Image size 848x848; modified Davis grading; nonmydriatic; NIDEK AFC-230 fundus camera; 45-degree field of view: 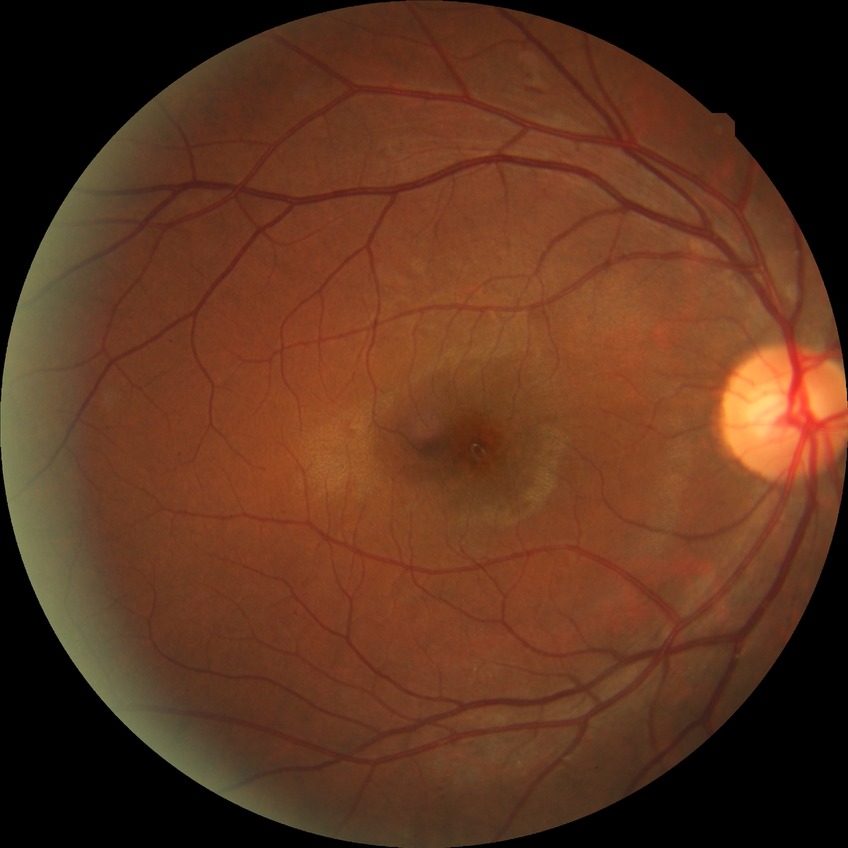
{
  "davis_grade": "SDR (simple diabetic retinopathy)"
}